FOV: 45 degrees:
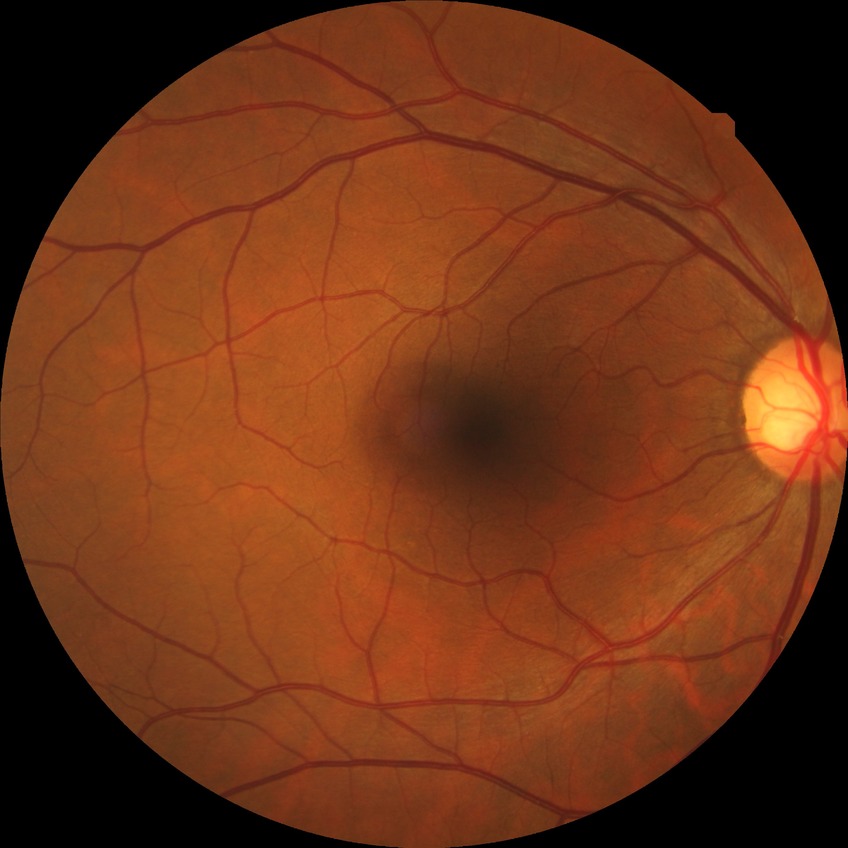 diabetic retinopathy (DR) = no diabetic retinopathy (NDR).